Image size 1932x1916. Fundus photo — 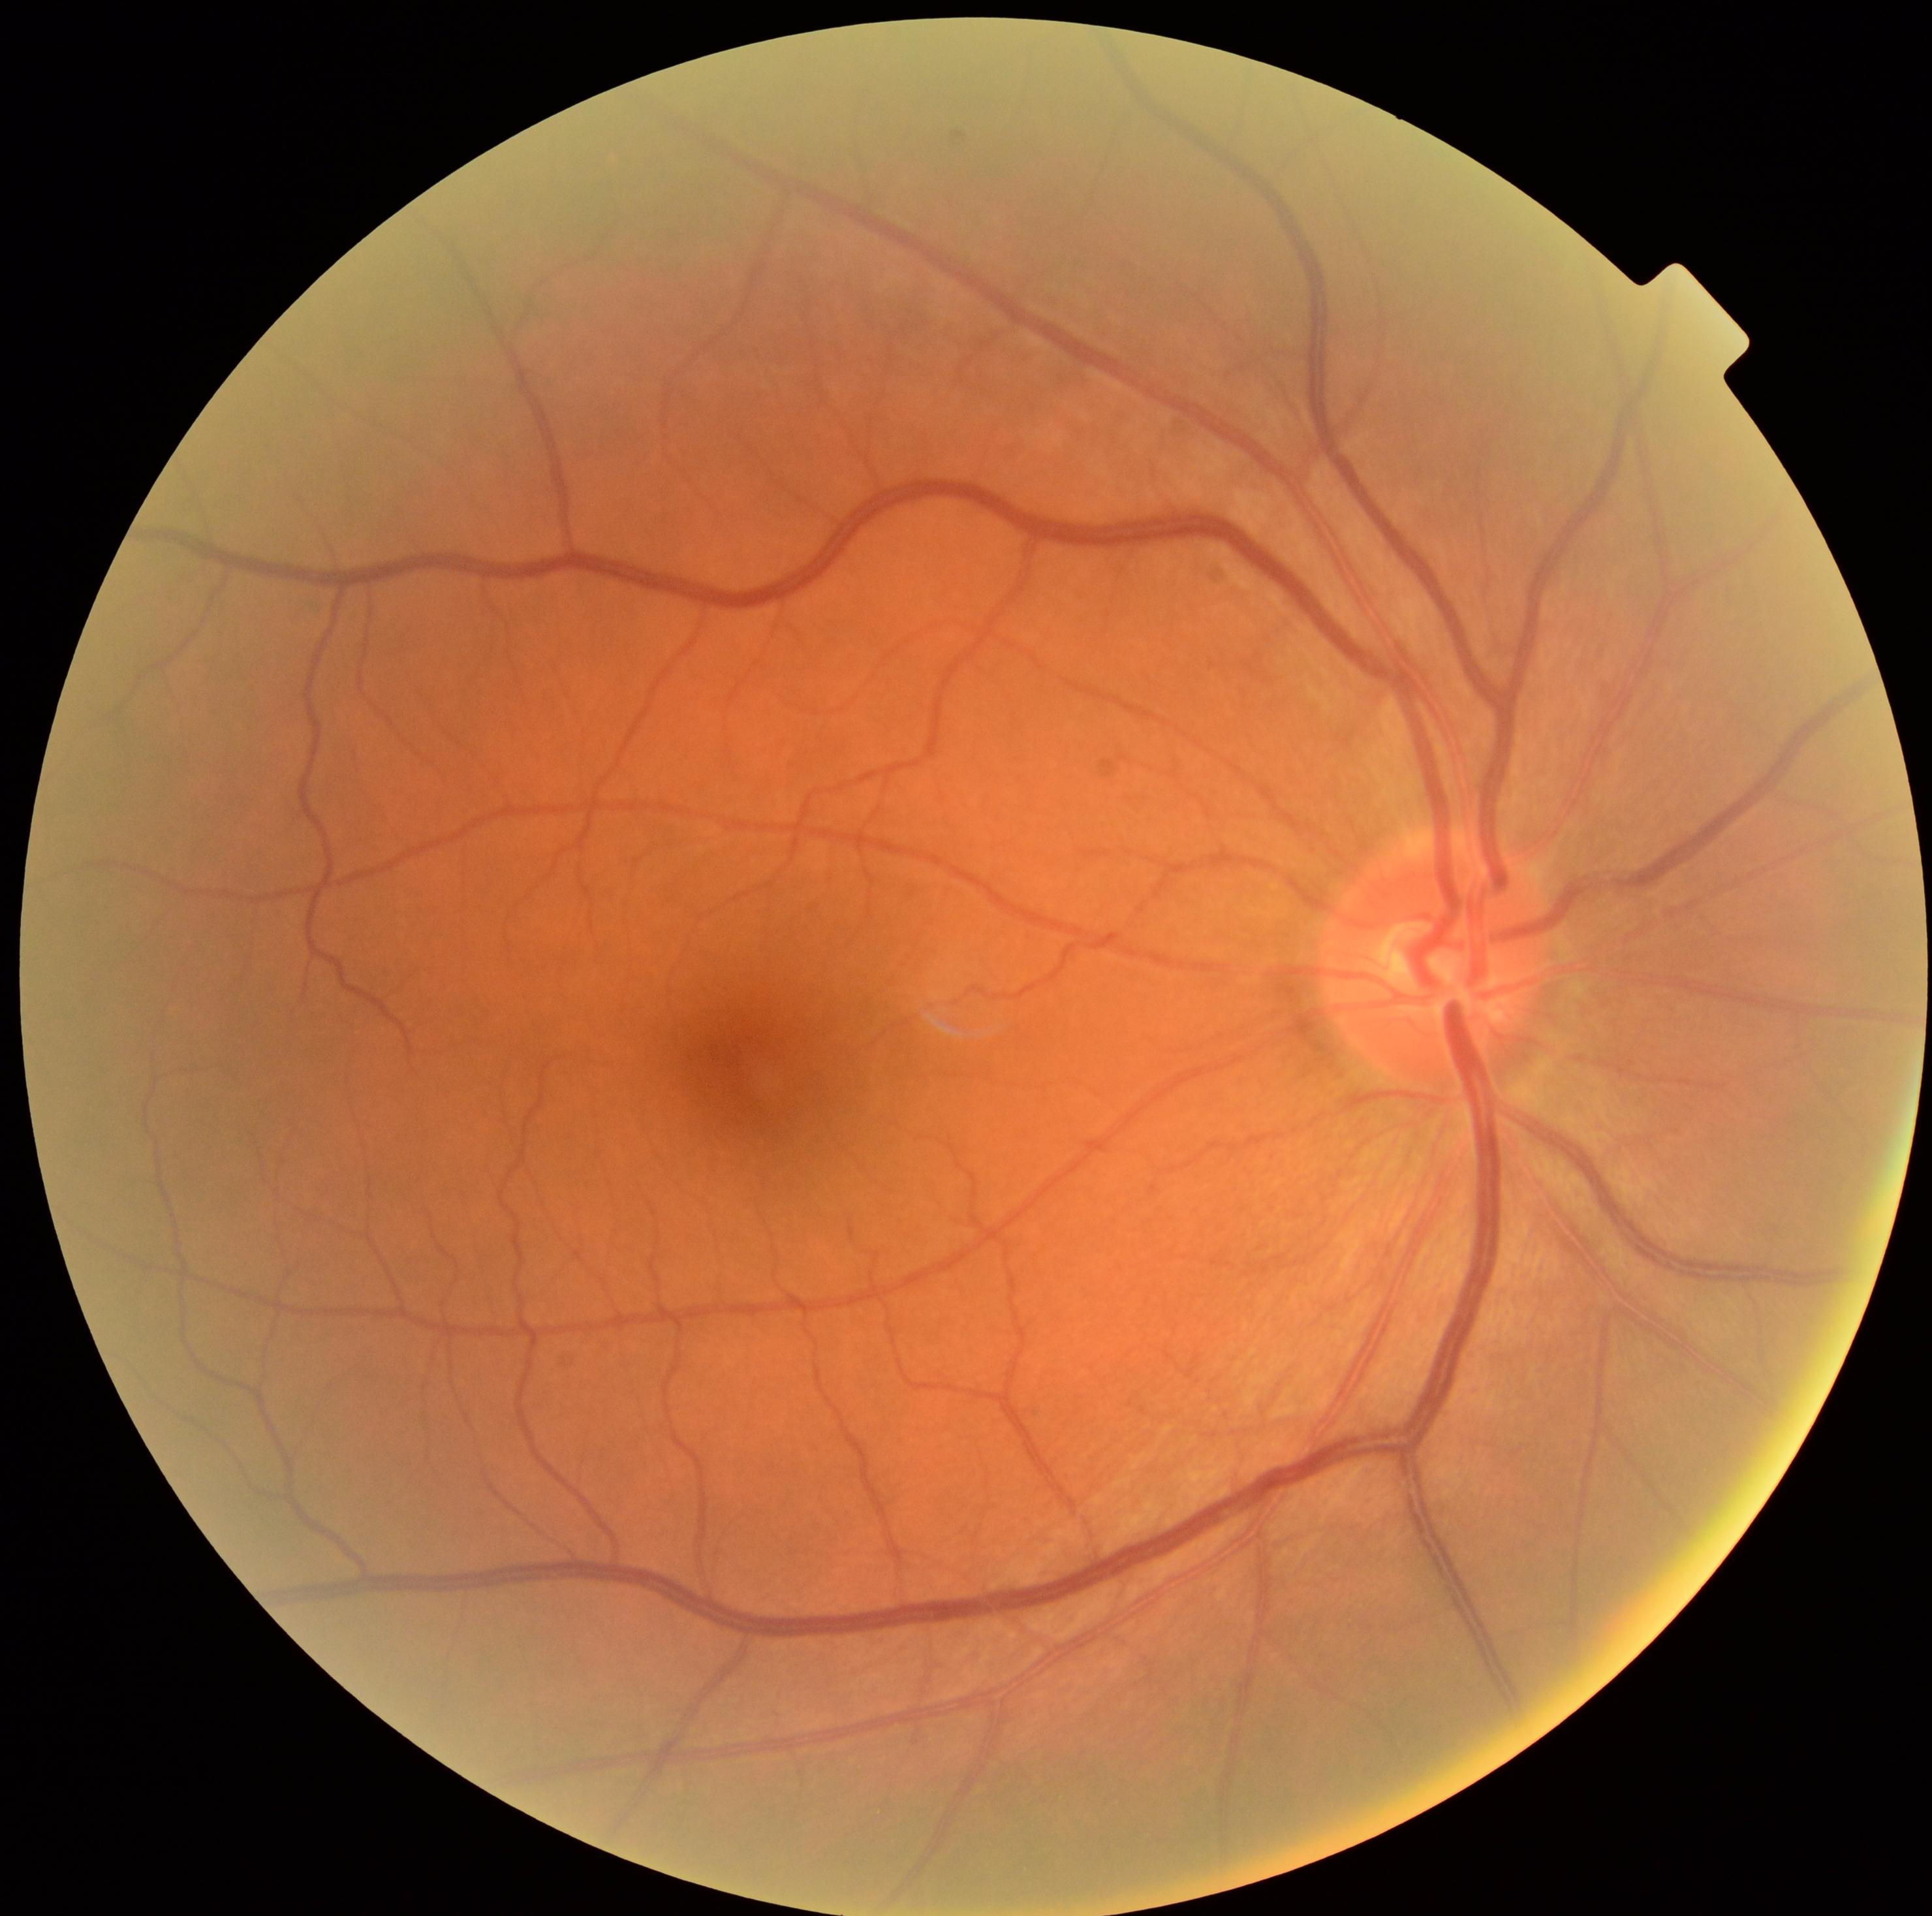 No diabetic retinal disease findings. Diabetic retinopathy grade is 0.